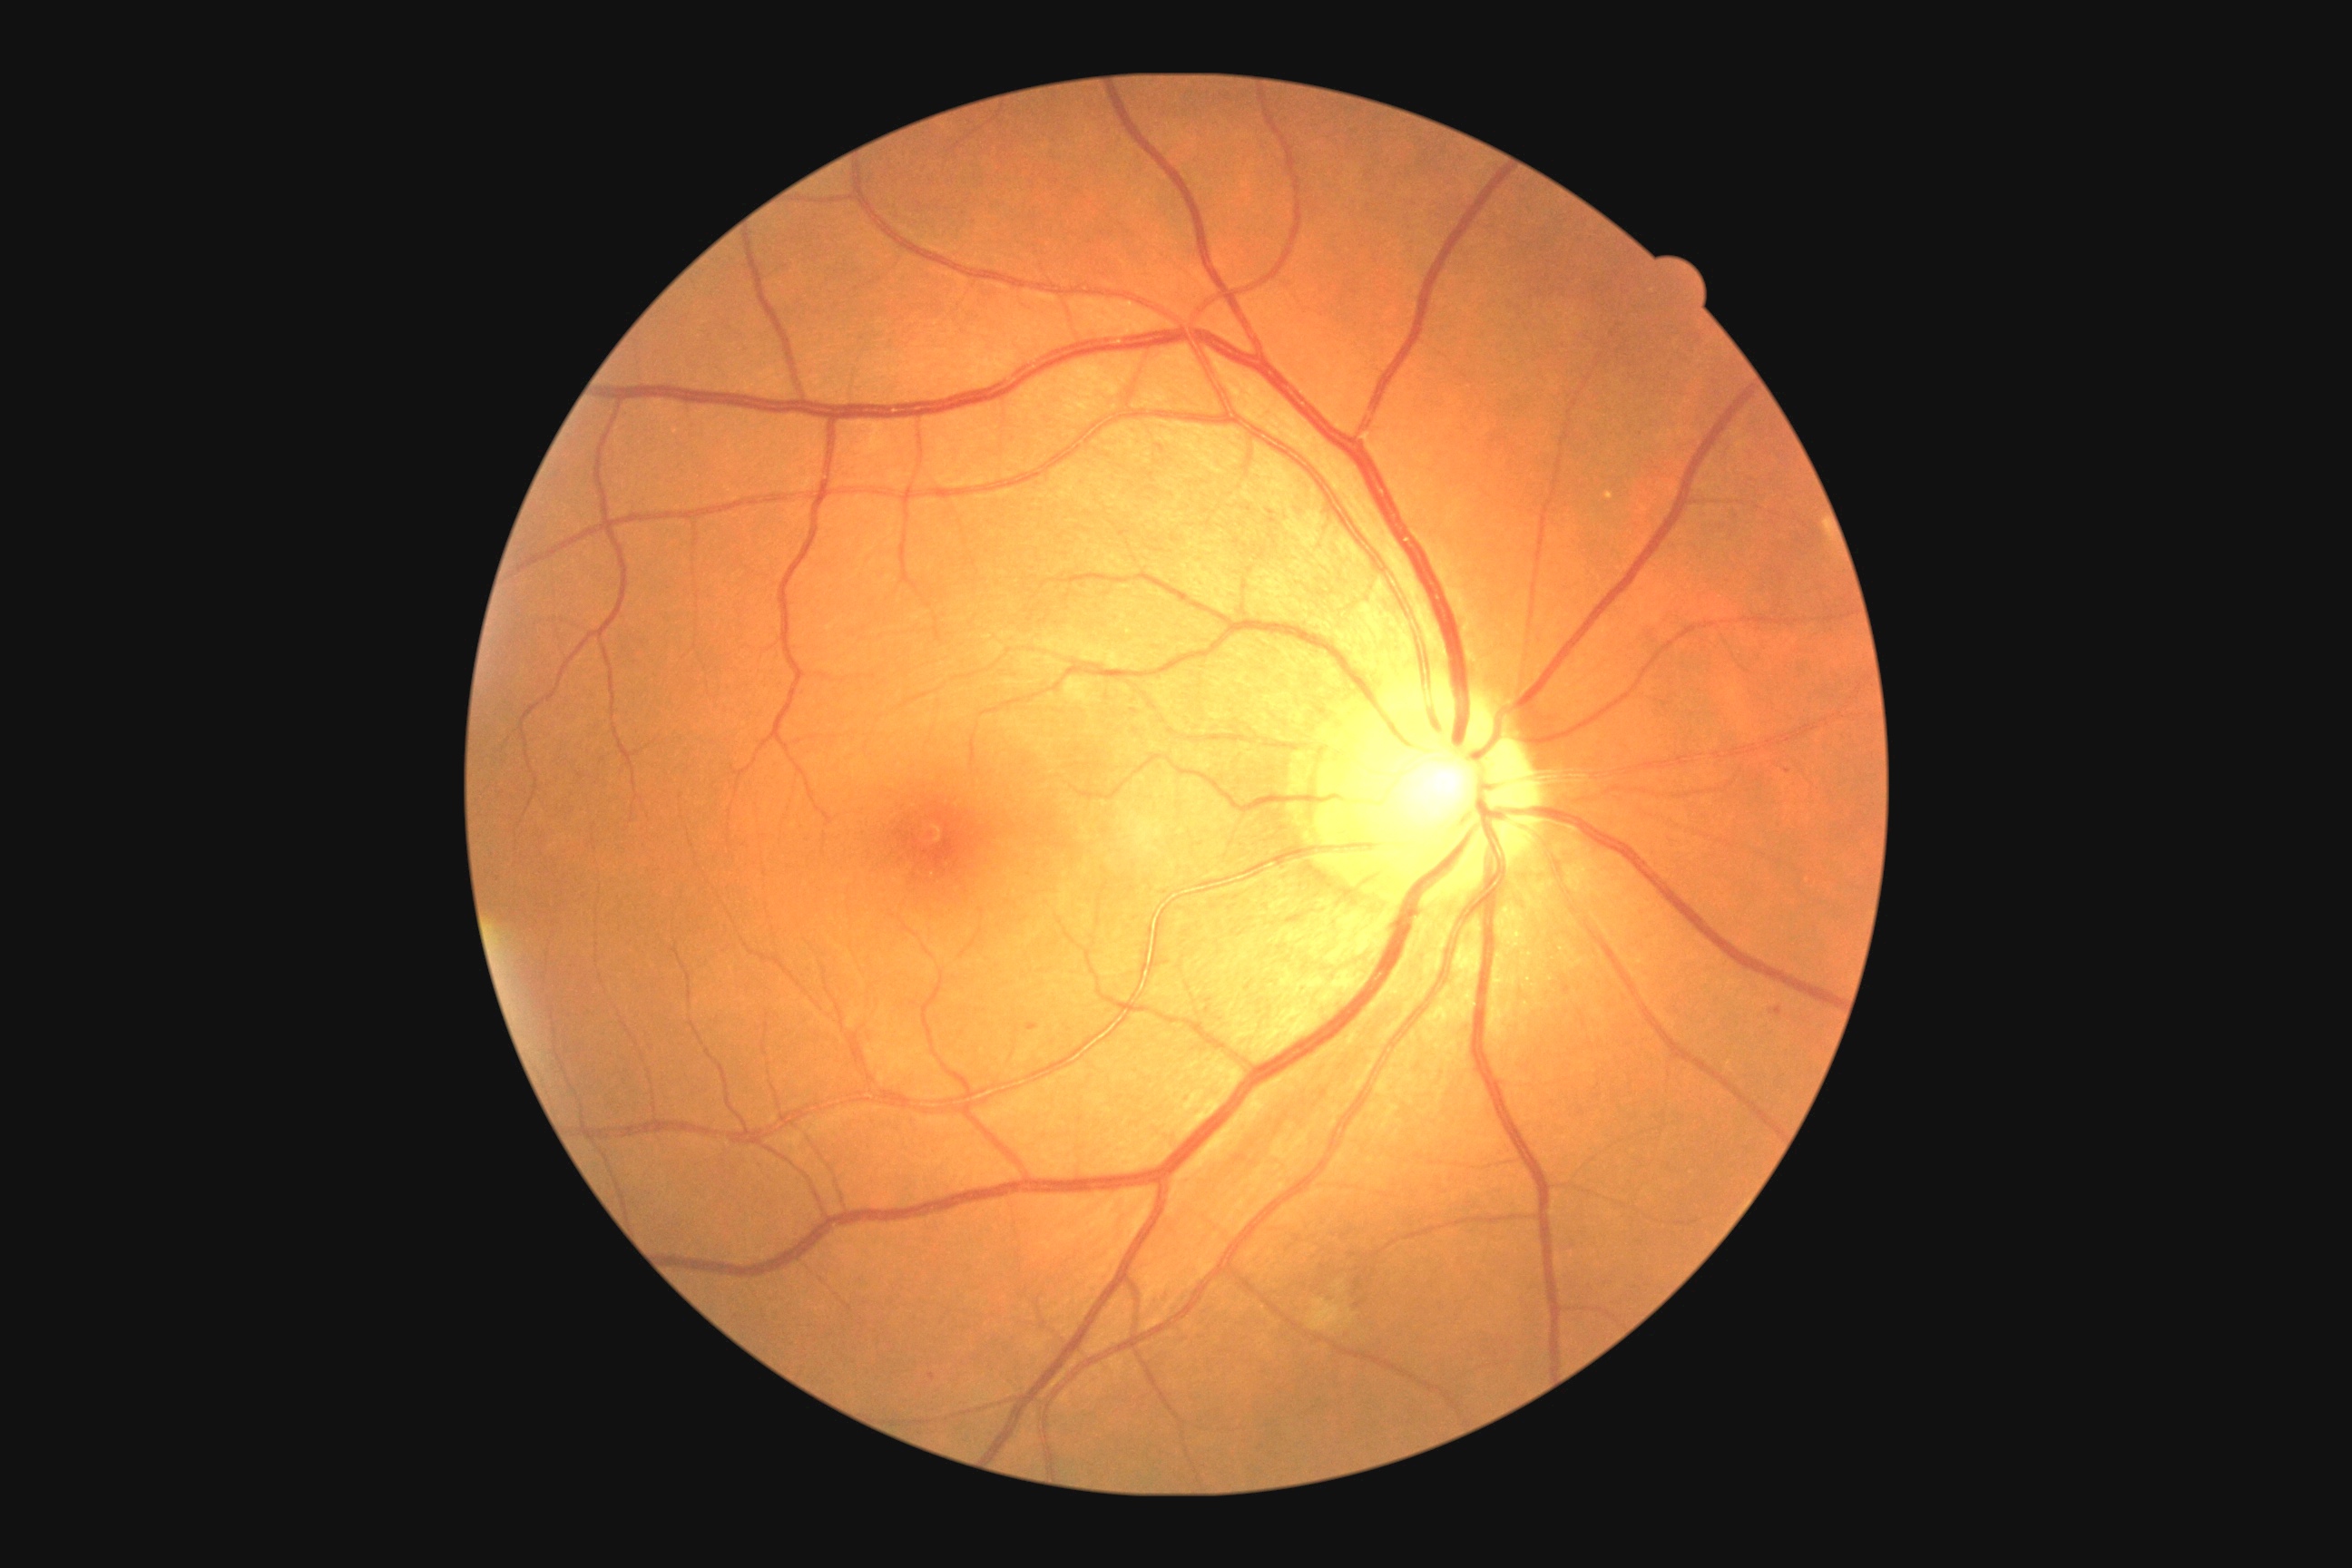
Diabetic retinopathy: 2; non-proliferative diabetic retinopathy.
Microaneurysms present at x1=1770 y1=1008 x2=1781 y2=1015 | x1=1026 y1=1023 x2=1039 y2=1032.
Microaneurysms (small, approximate centers) near (933, 1377) | (1360, 1305) | (1787, 772).
No hard exudates identified.
Soft exudates present at x1=1308 y1=1298 x2=1344 y2=1331.
No hemorrhages identified.